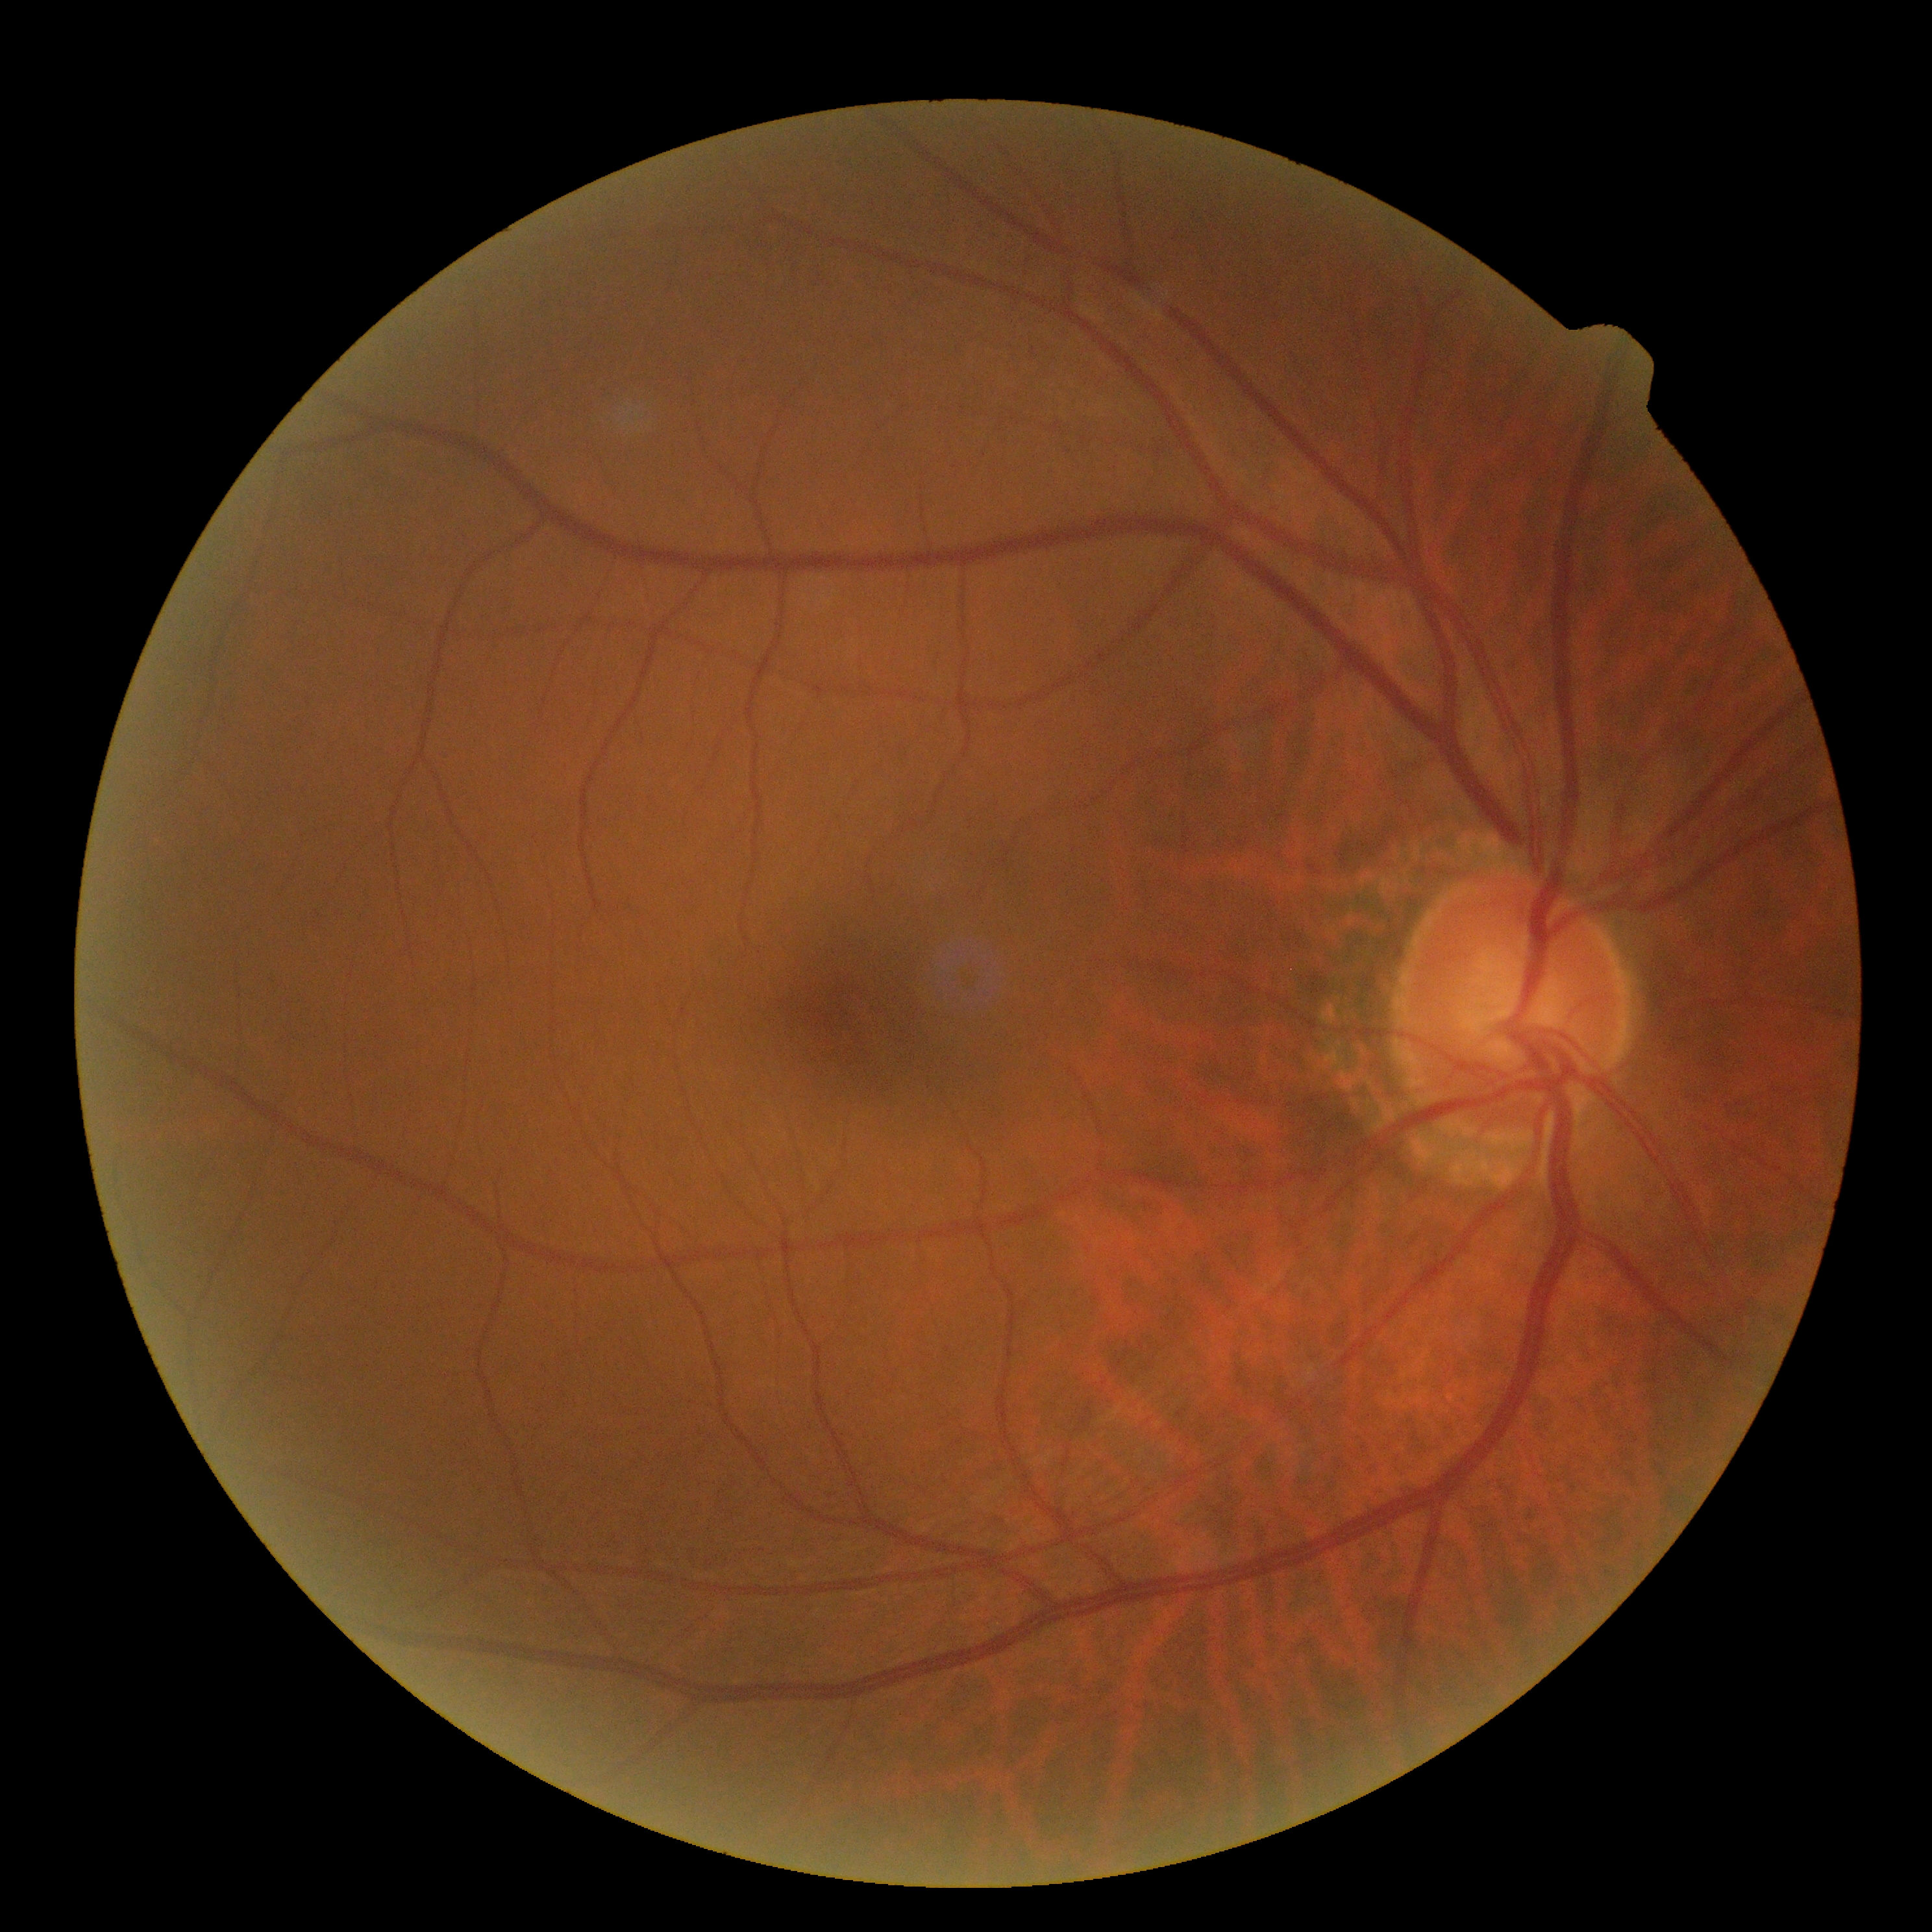

DR severity: grade 0 (no apparent retinopathy).